Image size 640x480. 130° field of view (Clarity RetCam 3). Wide-field fundus image from infant ROP screening
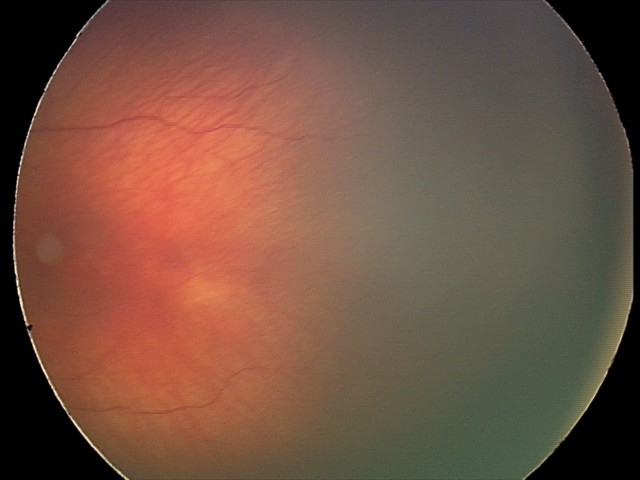
From an examination with diagnosis of status post retinopathy of prematurity (ROP).